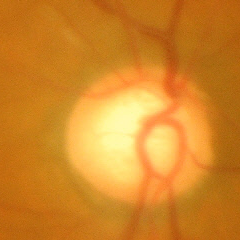

Q: Is glaucoma present?
A: Advanced glaucomatous optic neuropathy.